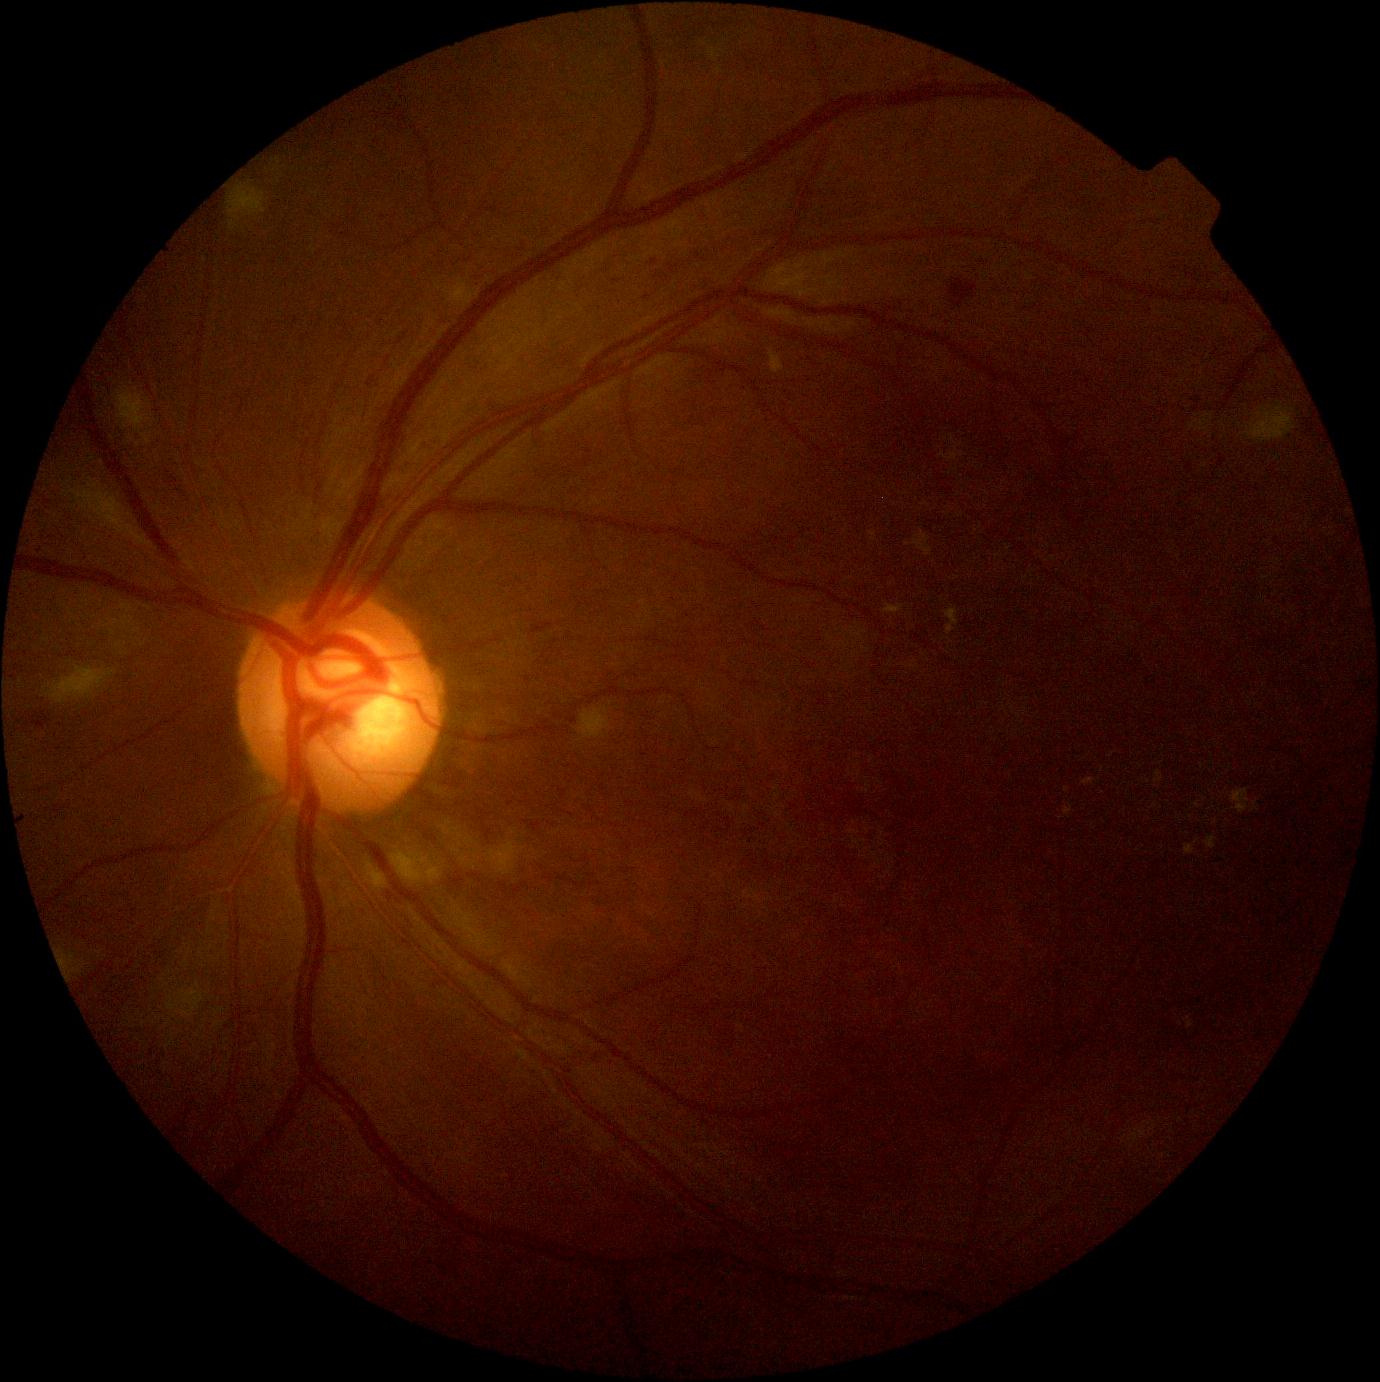
Retinopathy is moderate NPDR (grade 2).